Fundus photo — 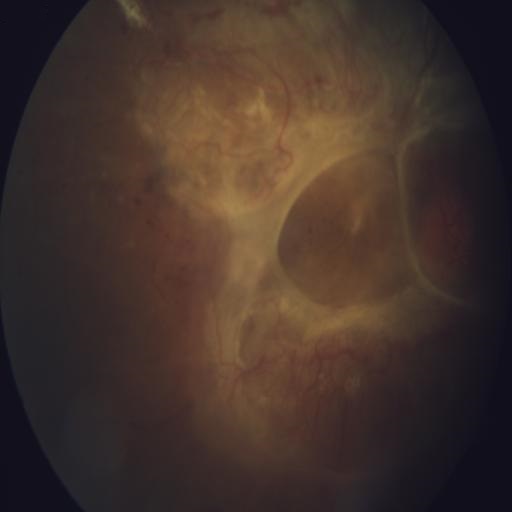 Two findings. Showing cystoid macular edema and retinal traction.